2048 by 1536 pixels; 45° FOV; color fundus photograph:
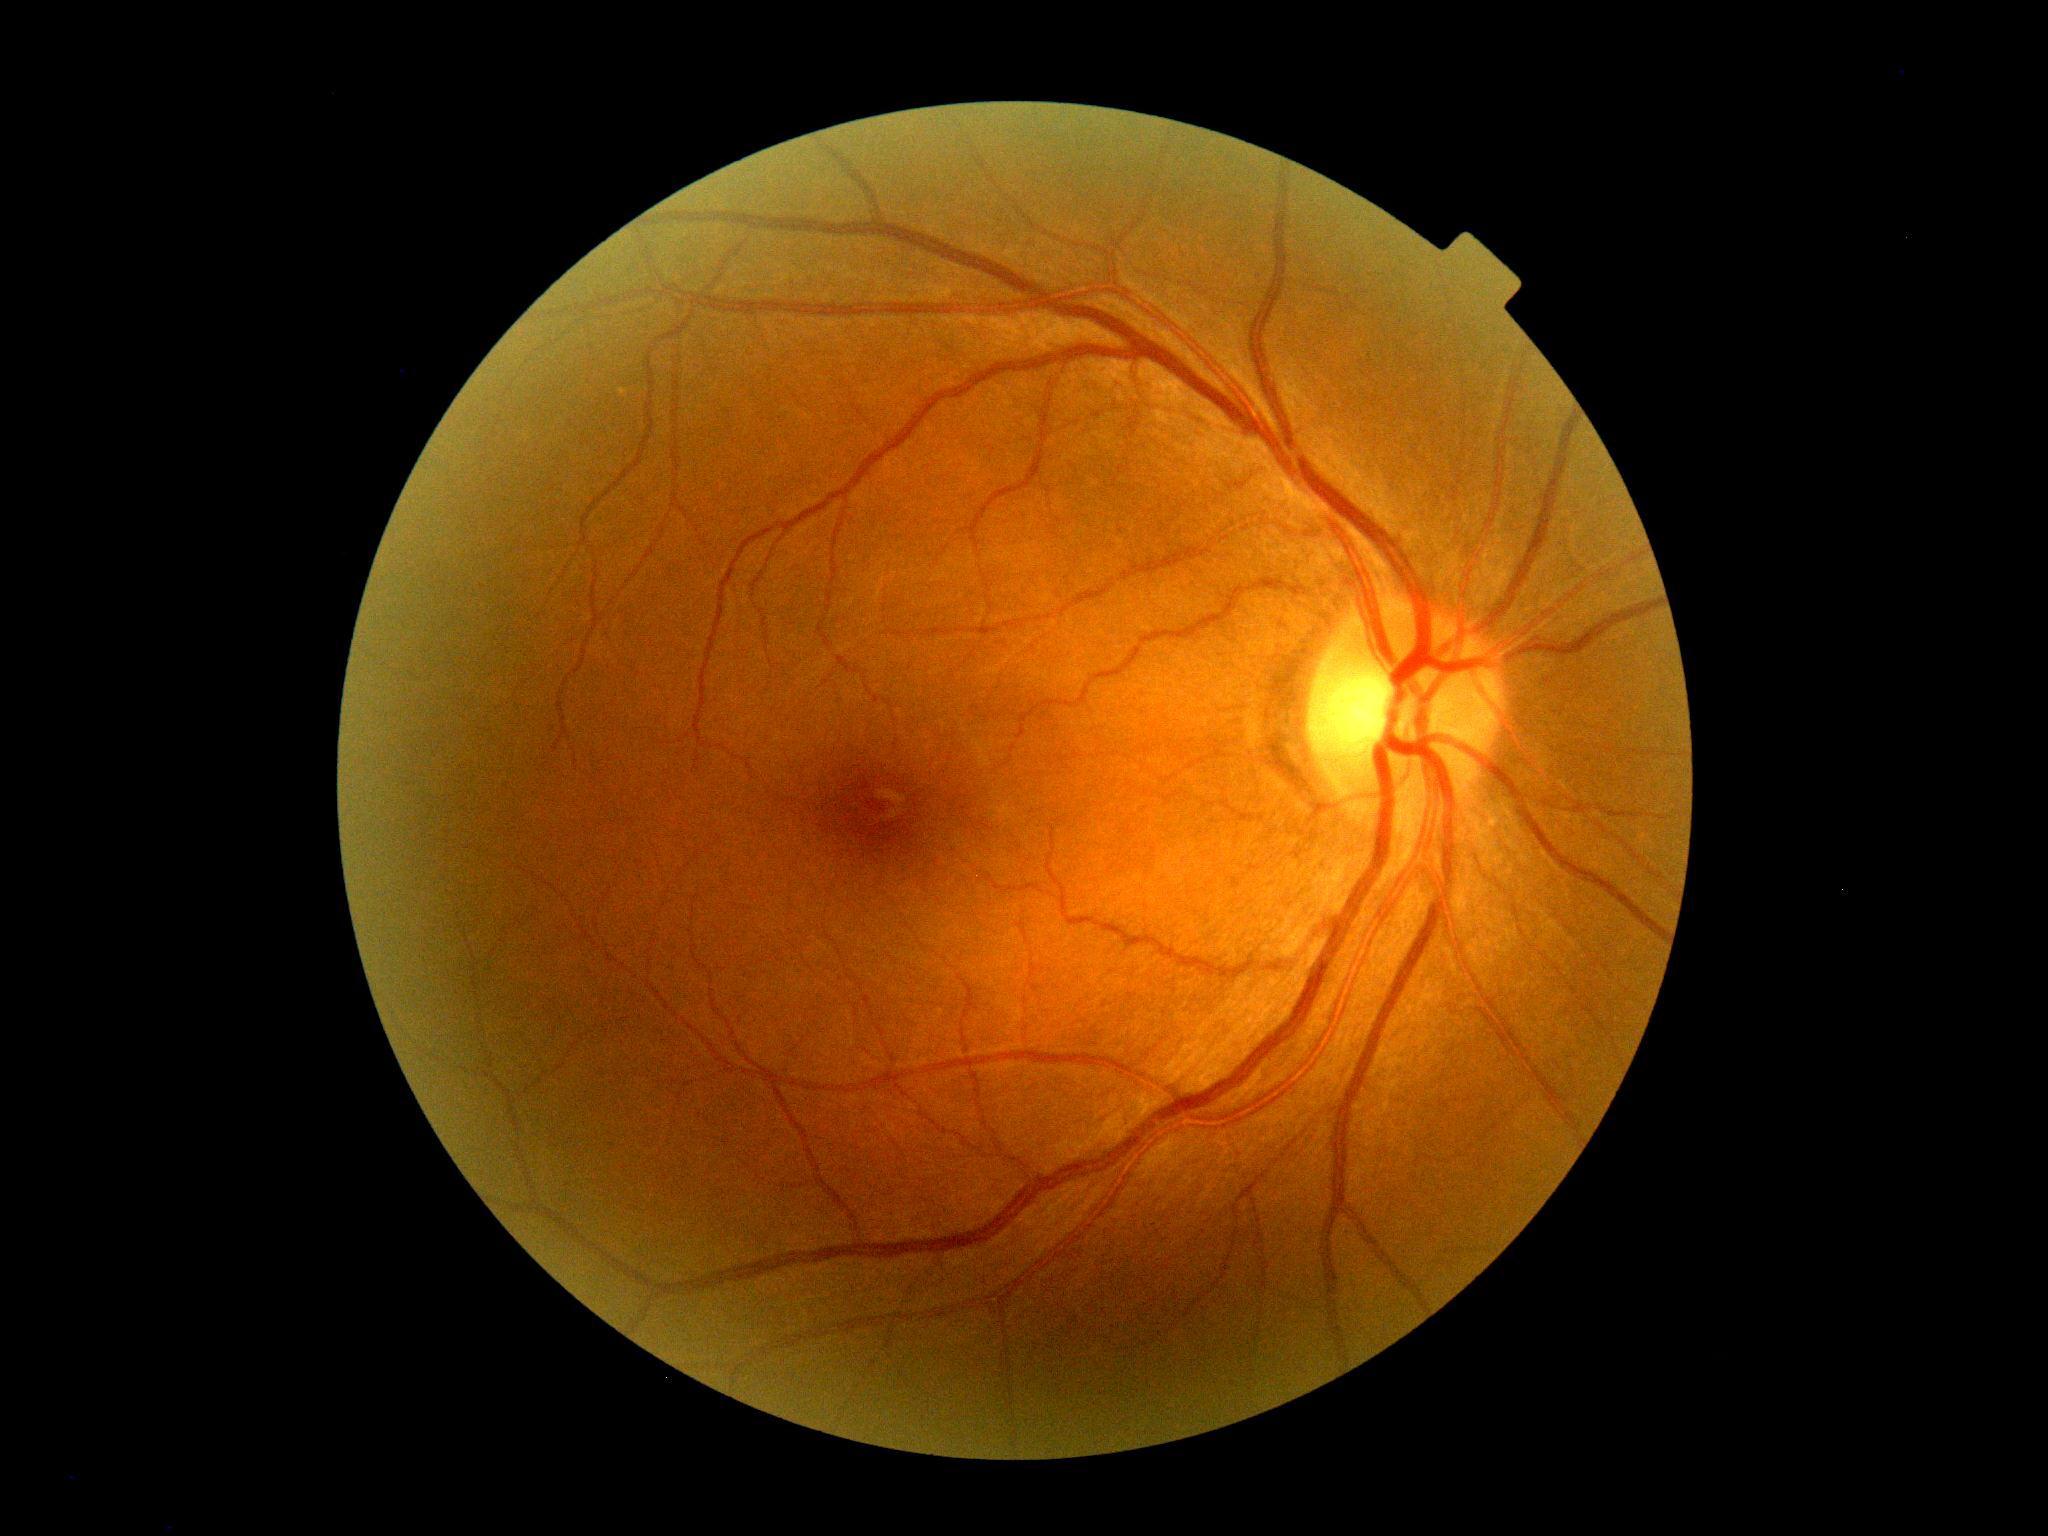
{
  "dr_grade": "no apparent diabetic retinopathy (grade 0)"
}